Posterior pole photograph · 45 degree fundus photograph · 848 by 848 pixels.
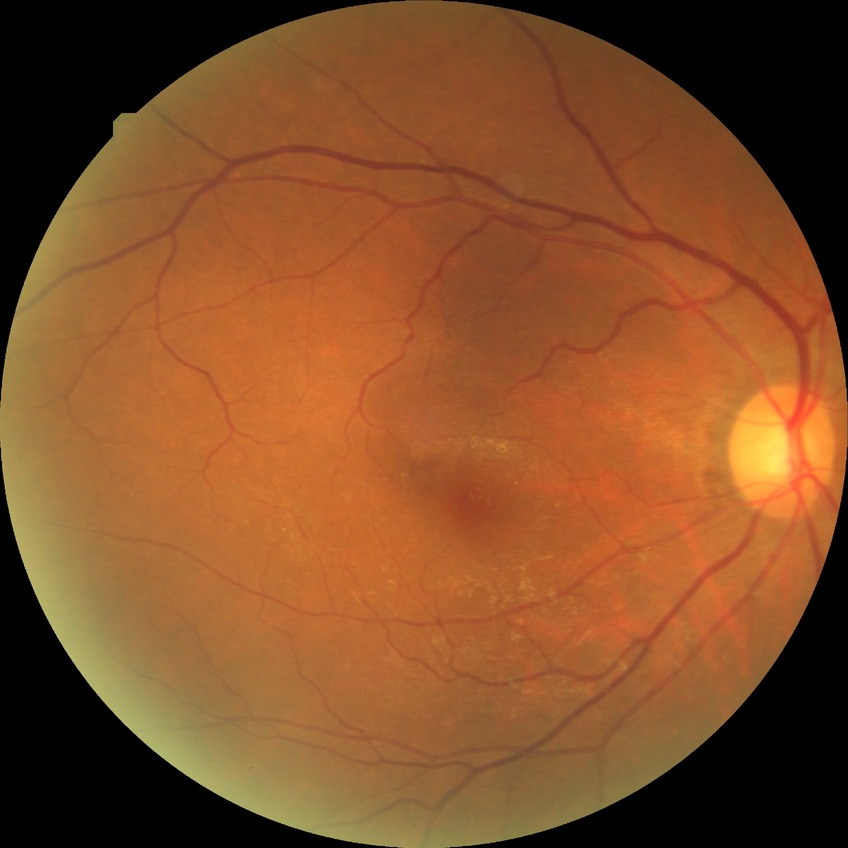
DR stage: NDR, DR impression: negative for DR.